Wide-field fundus photograph of an infant:
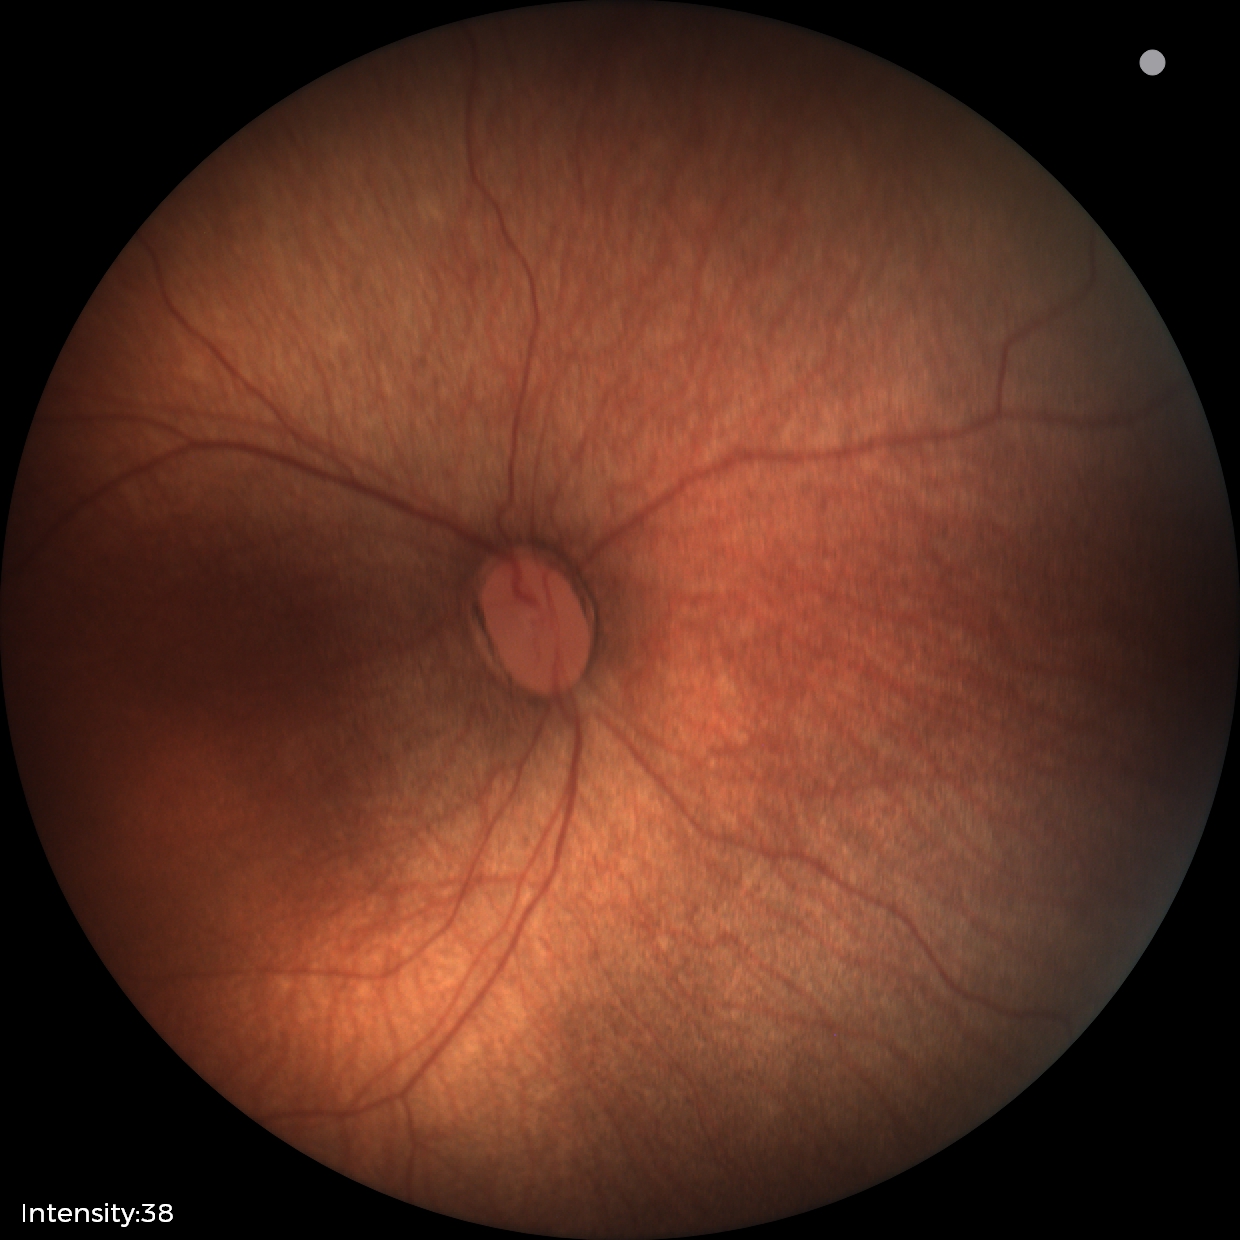 Examination diagnosed as status post ROP. Without plus disease.